2346x1568px, color fundus photograph.
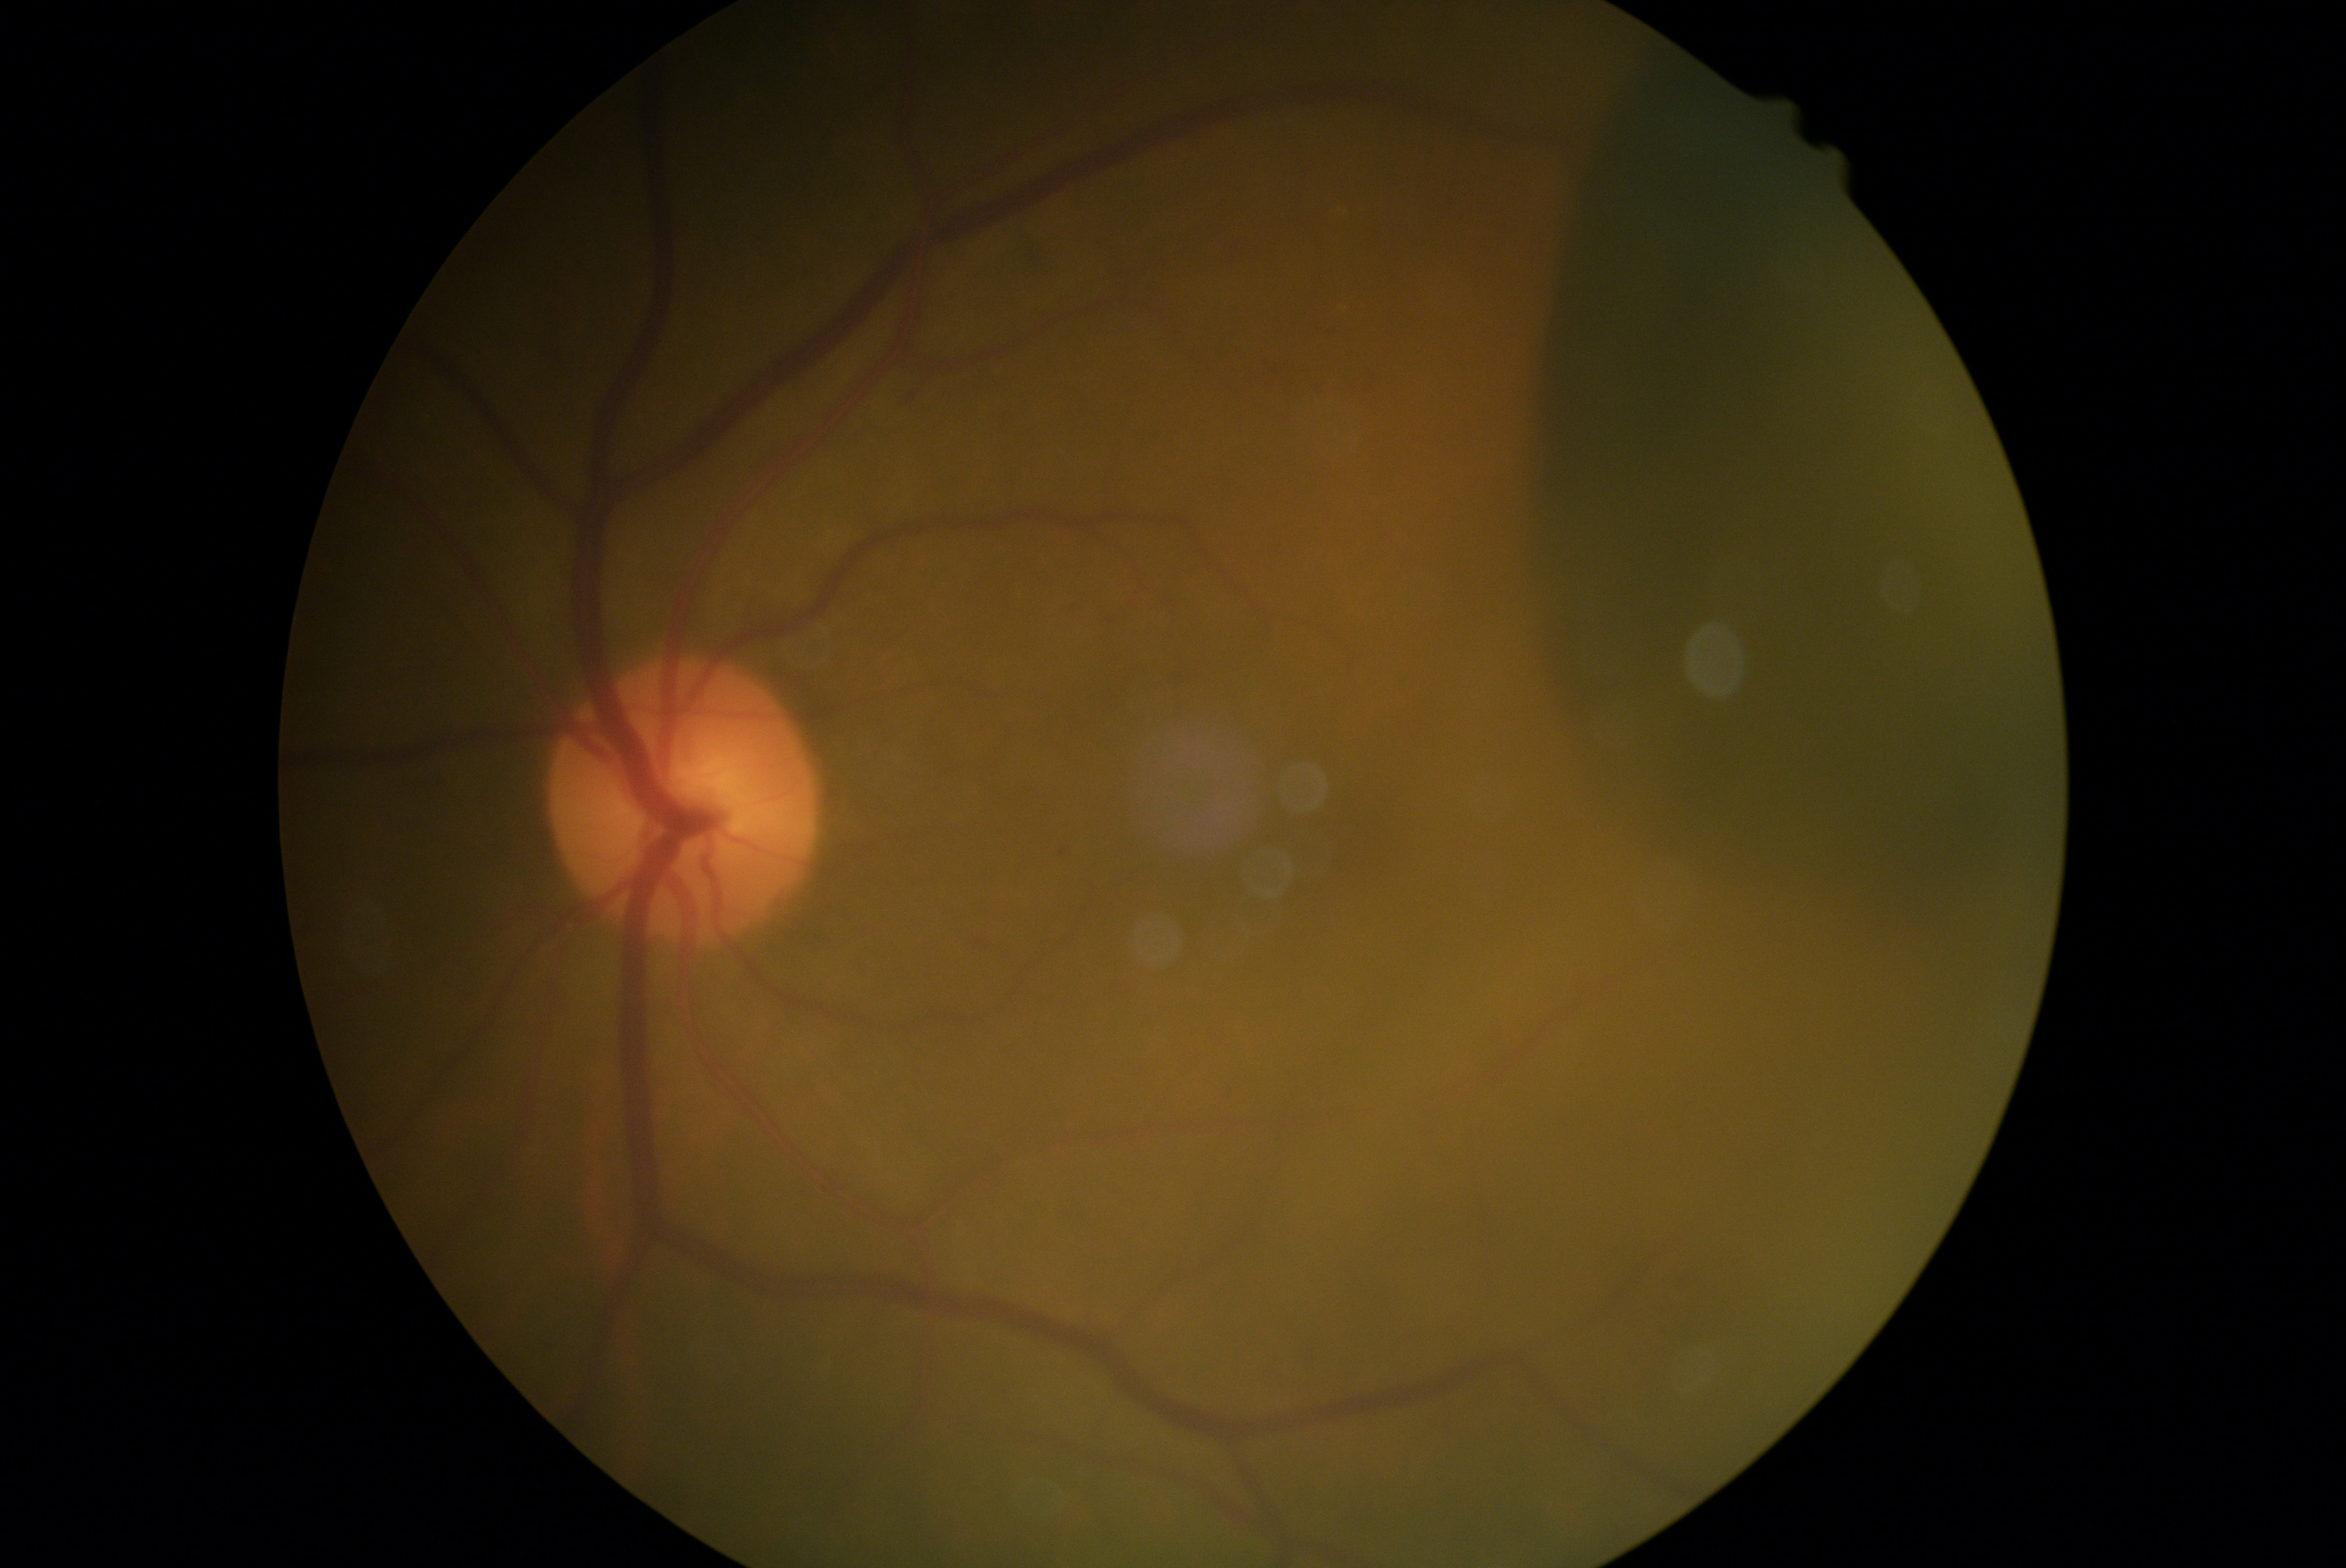
DR: proliferative diabetic retinopathy (grade 4).
The retinopathy is classified as proliferative diabetic retinopathy.